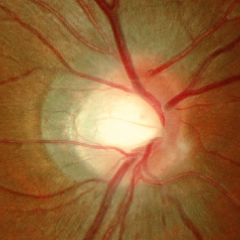
Fundus image with findings of no signs of glaucoma.